Nonmydriatic fundus photograph: 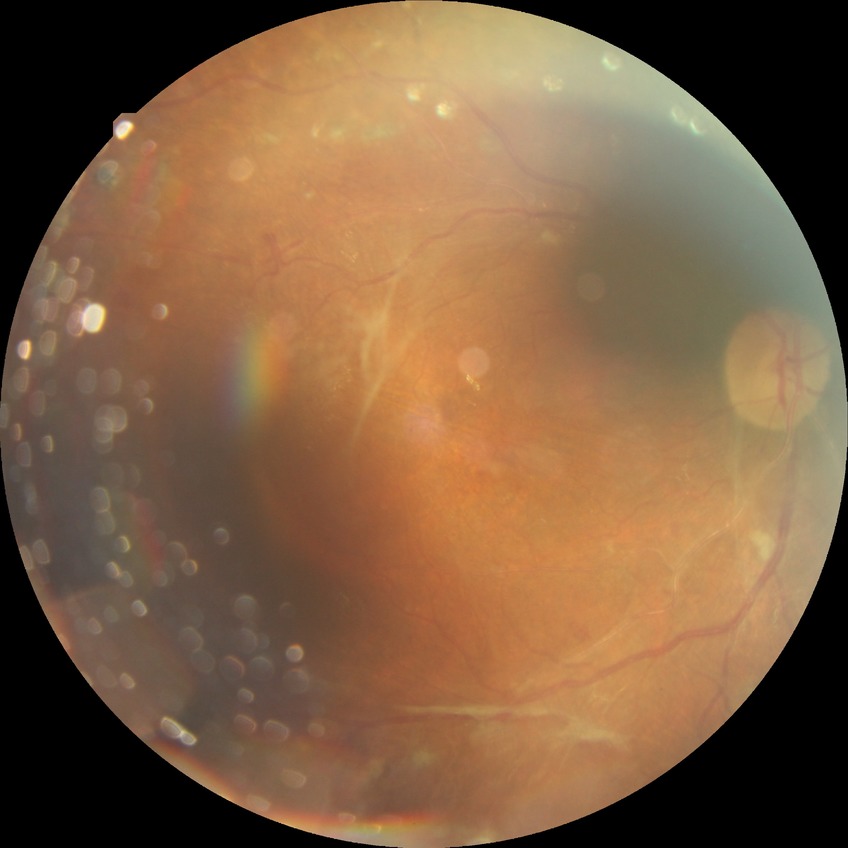 retinopathy grade = proliferative diabetic retinopathy.